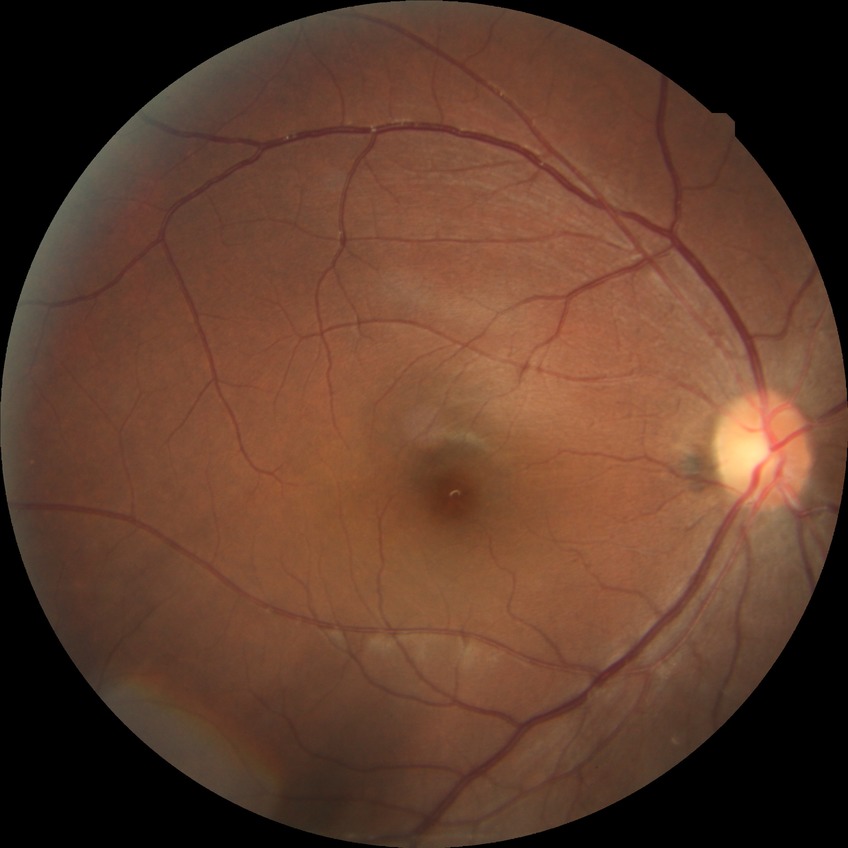

Diabetic retinopathy stage is no diabetic retinopathy.